848 x 848 pixels · nonmydriatic fundus photograph · FOV: 45 degrees.
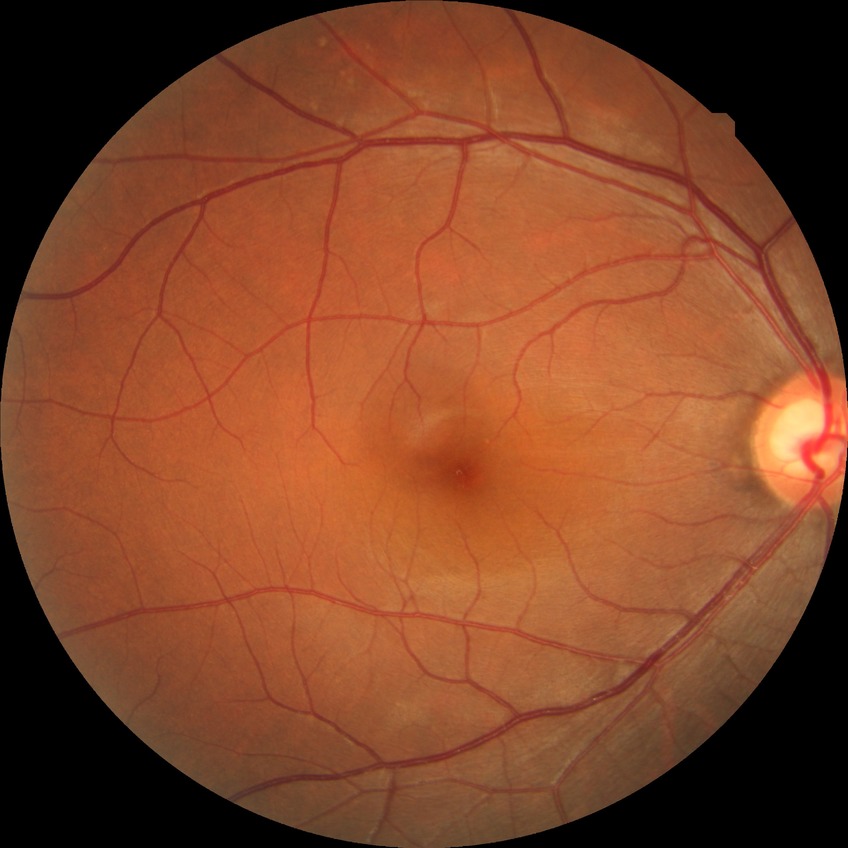
Modified Davis classification: no diabetic retinopathy.